848x848px; nonmydriatic fundus photograph
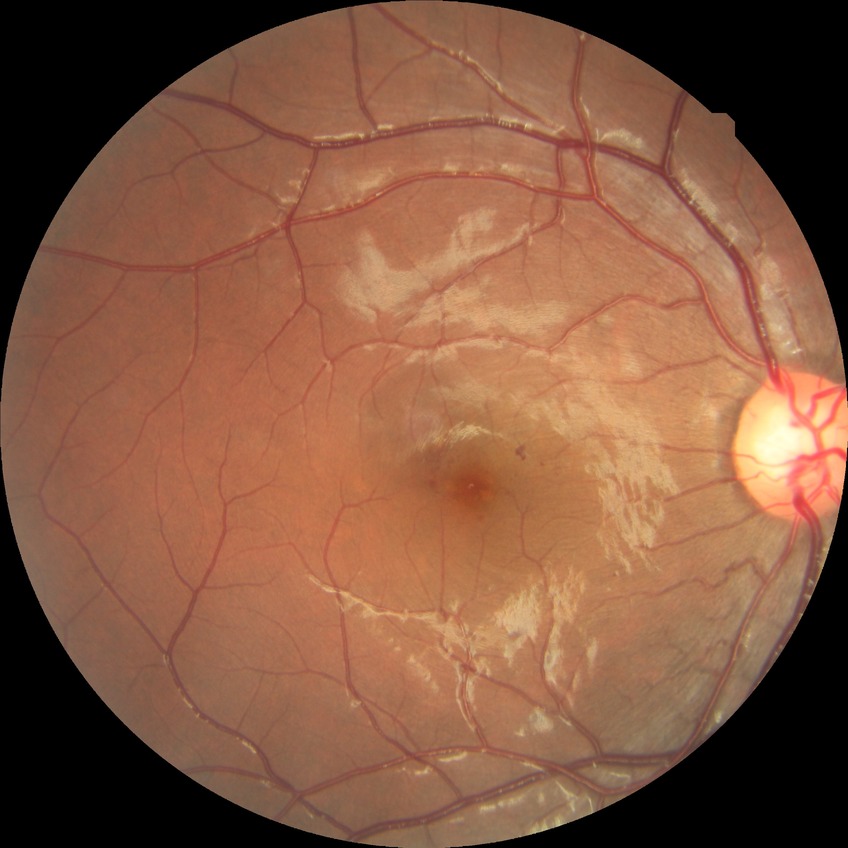

Diabetic retinopathy (DR): SDR (simple diabetic retinopathy).